Without pupil dilation; Davis DR grading; 848x848 — 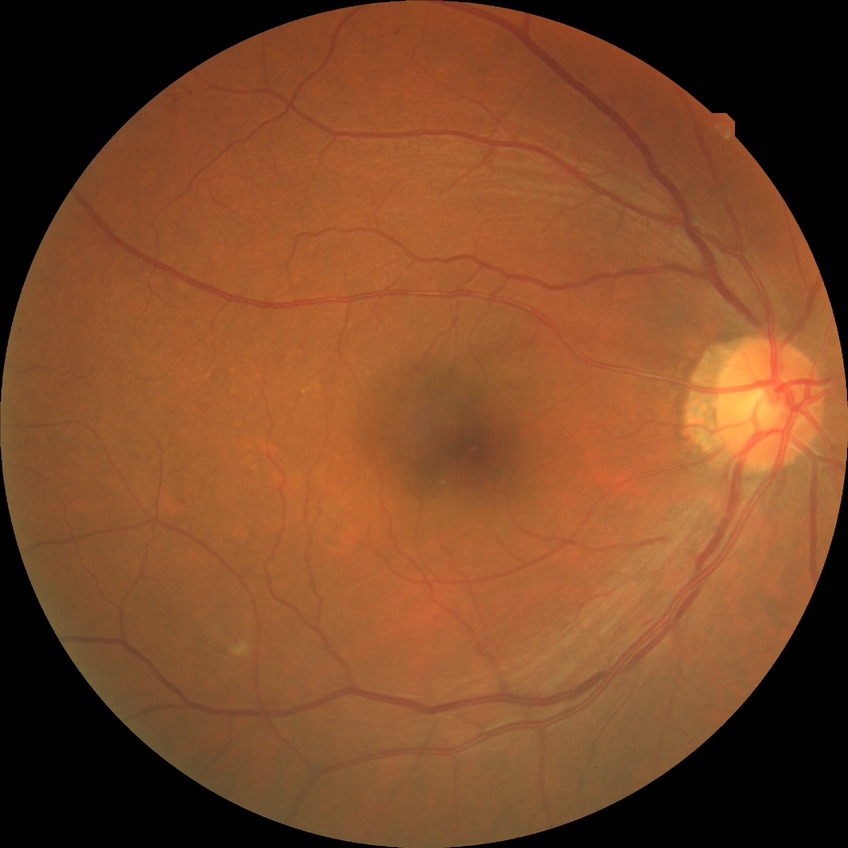

davis_grade: simple diabetic retinopathy (SDR)